45° FOV
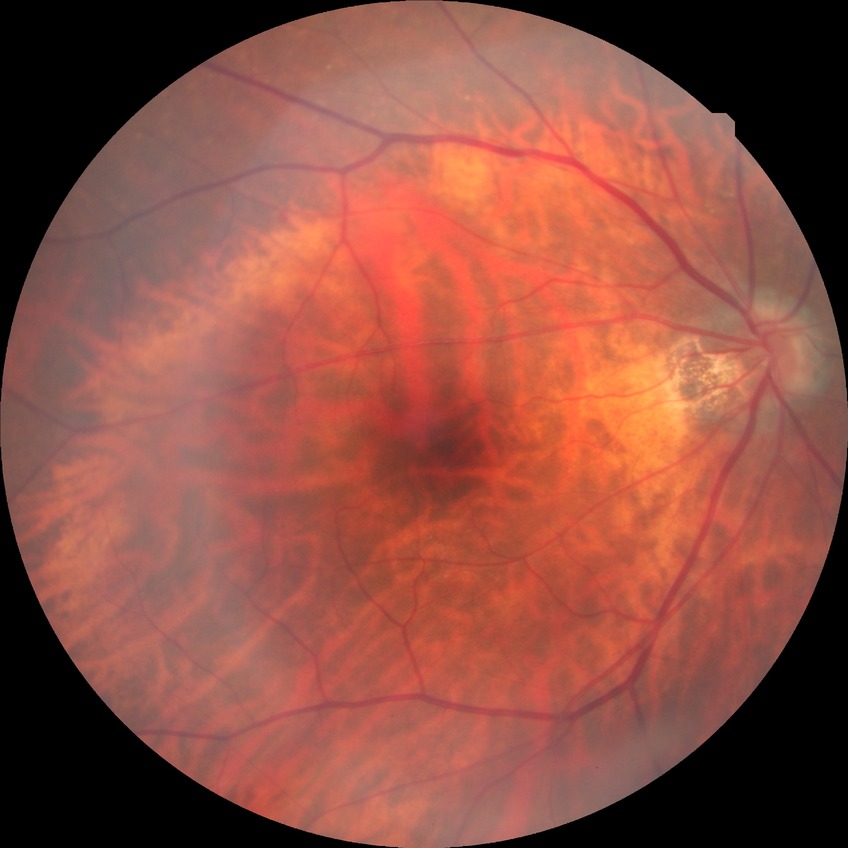 davis_grade: no diabetic retinopathy (NDR)